Wide-field contact fundus photograph of an infant.
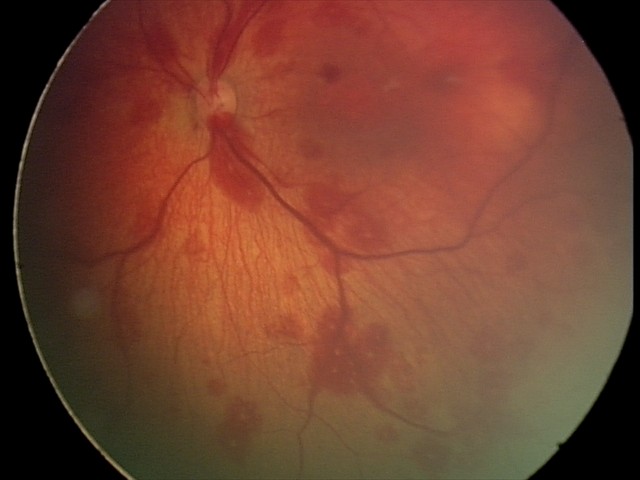
Diagnosis: retinal hemorrhages.